Color fundus image: 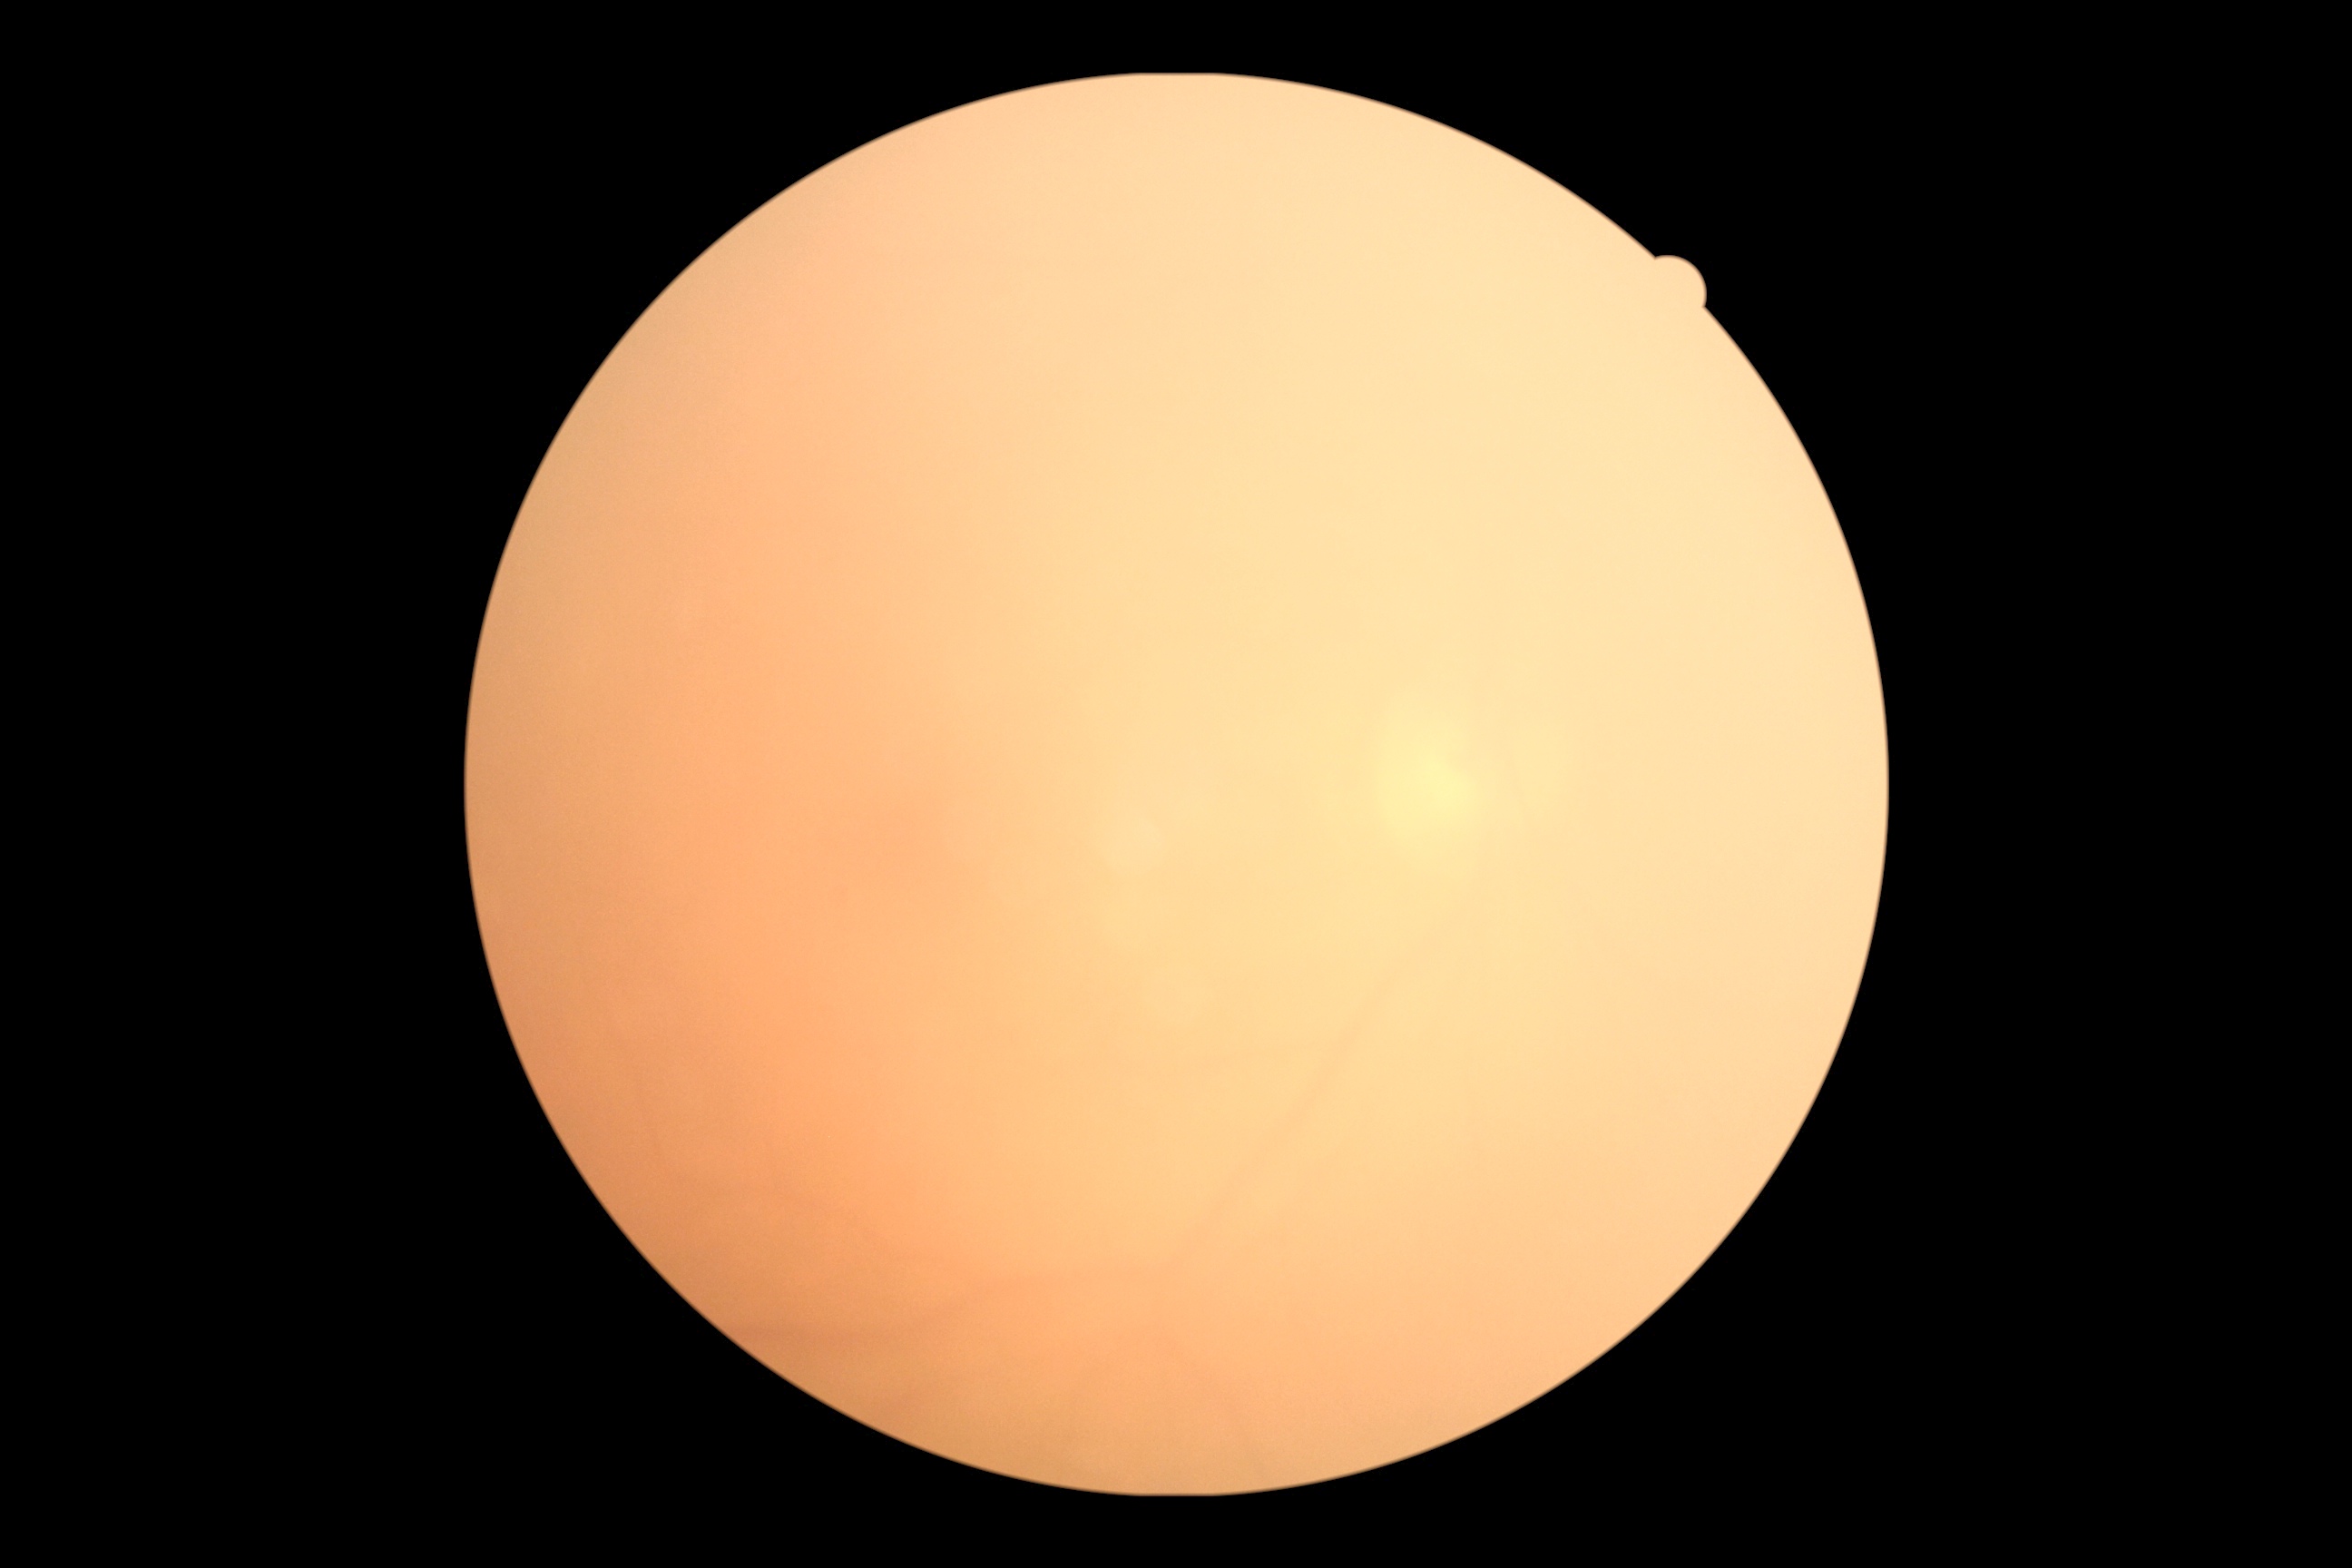 DR severity: ungradable.